Color fundus photograph:
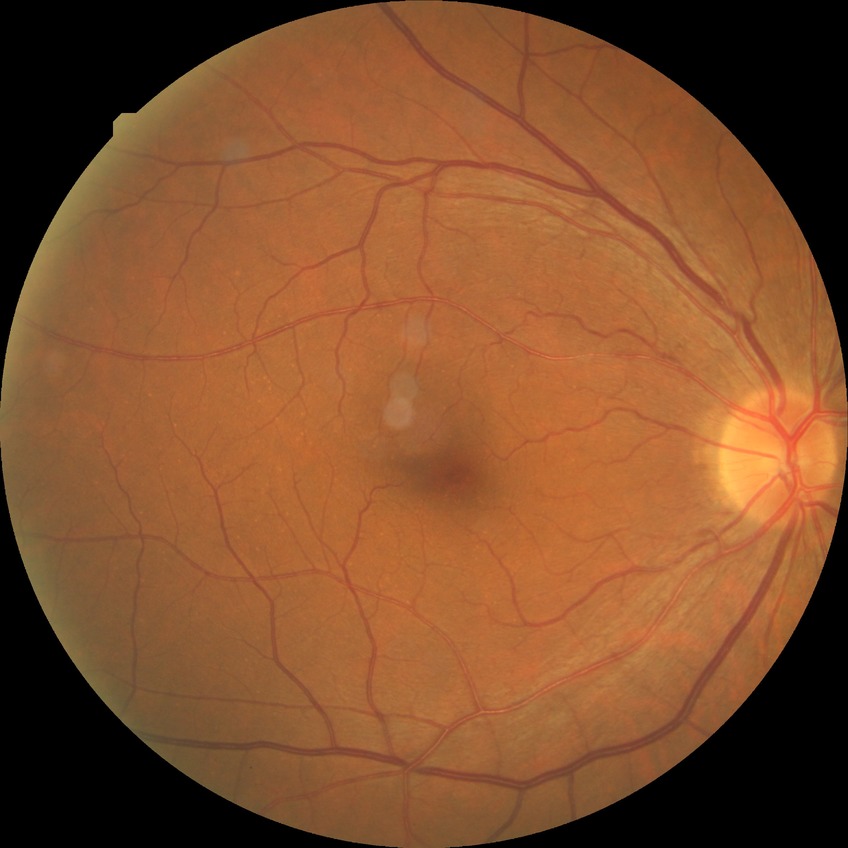 diabetic retinopathy (DR): NDR (no diabetic retinopathy).